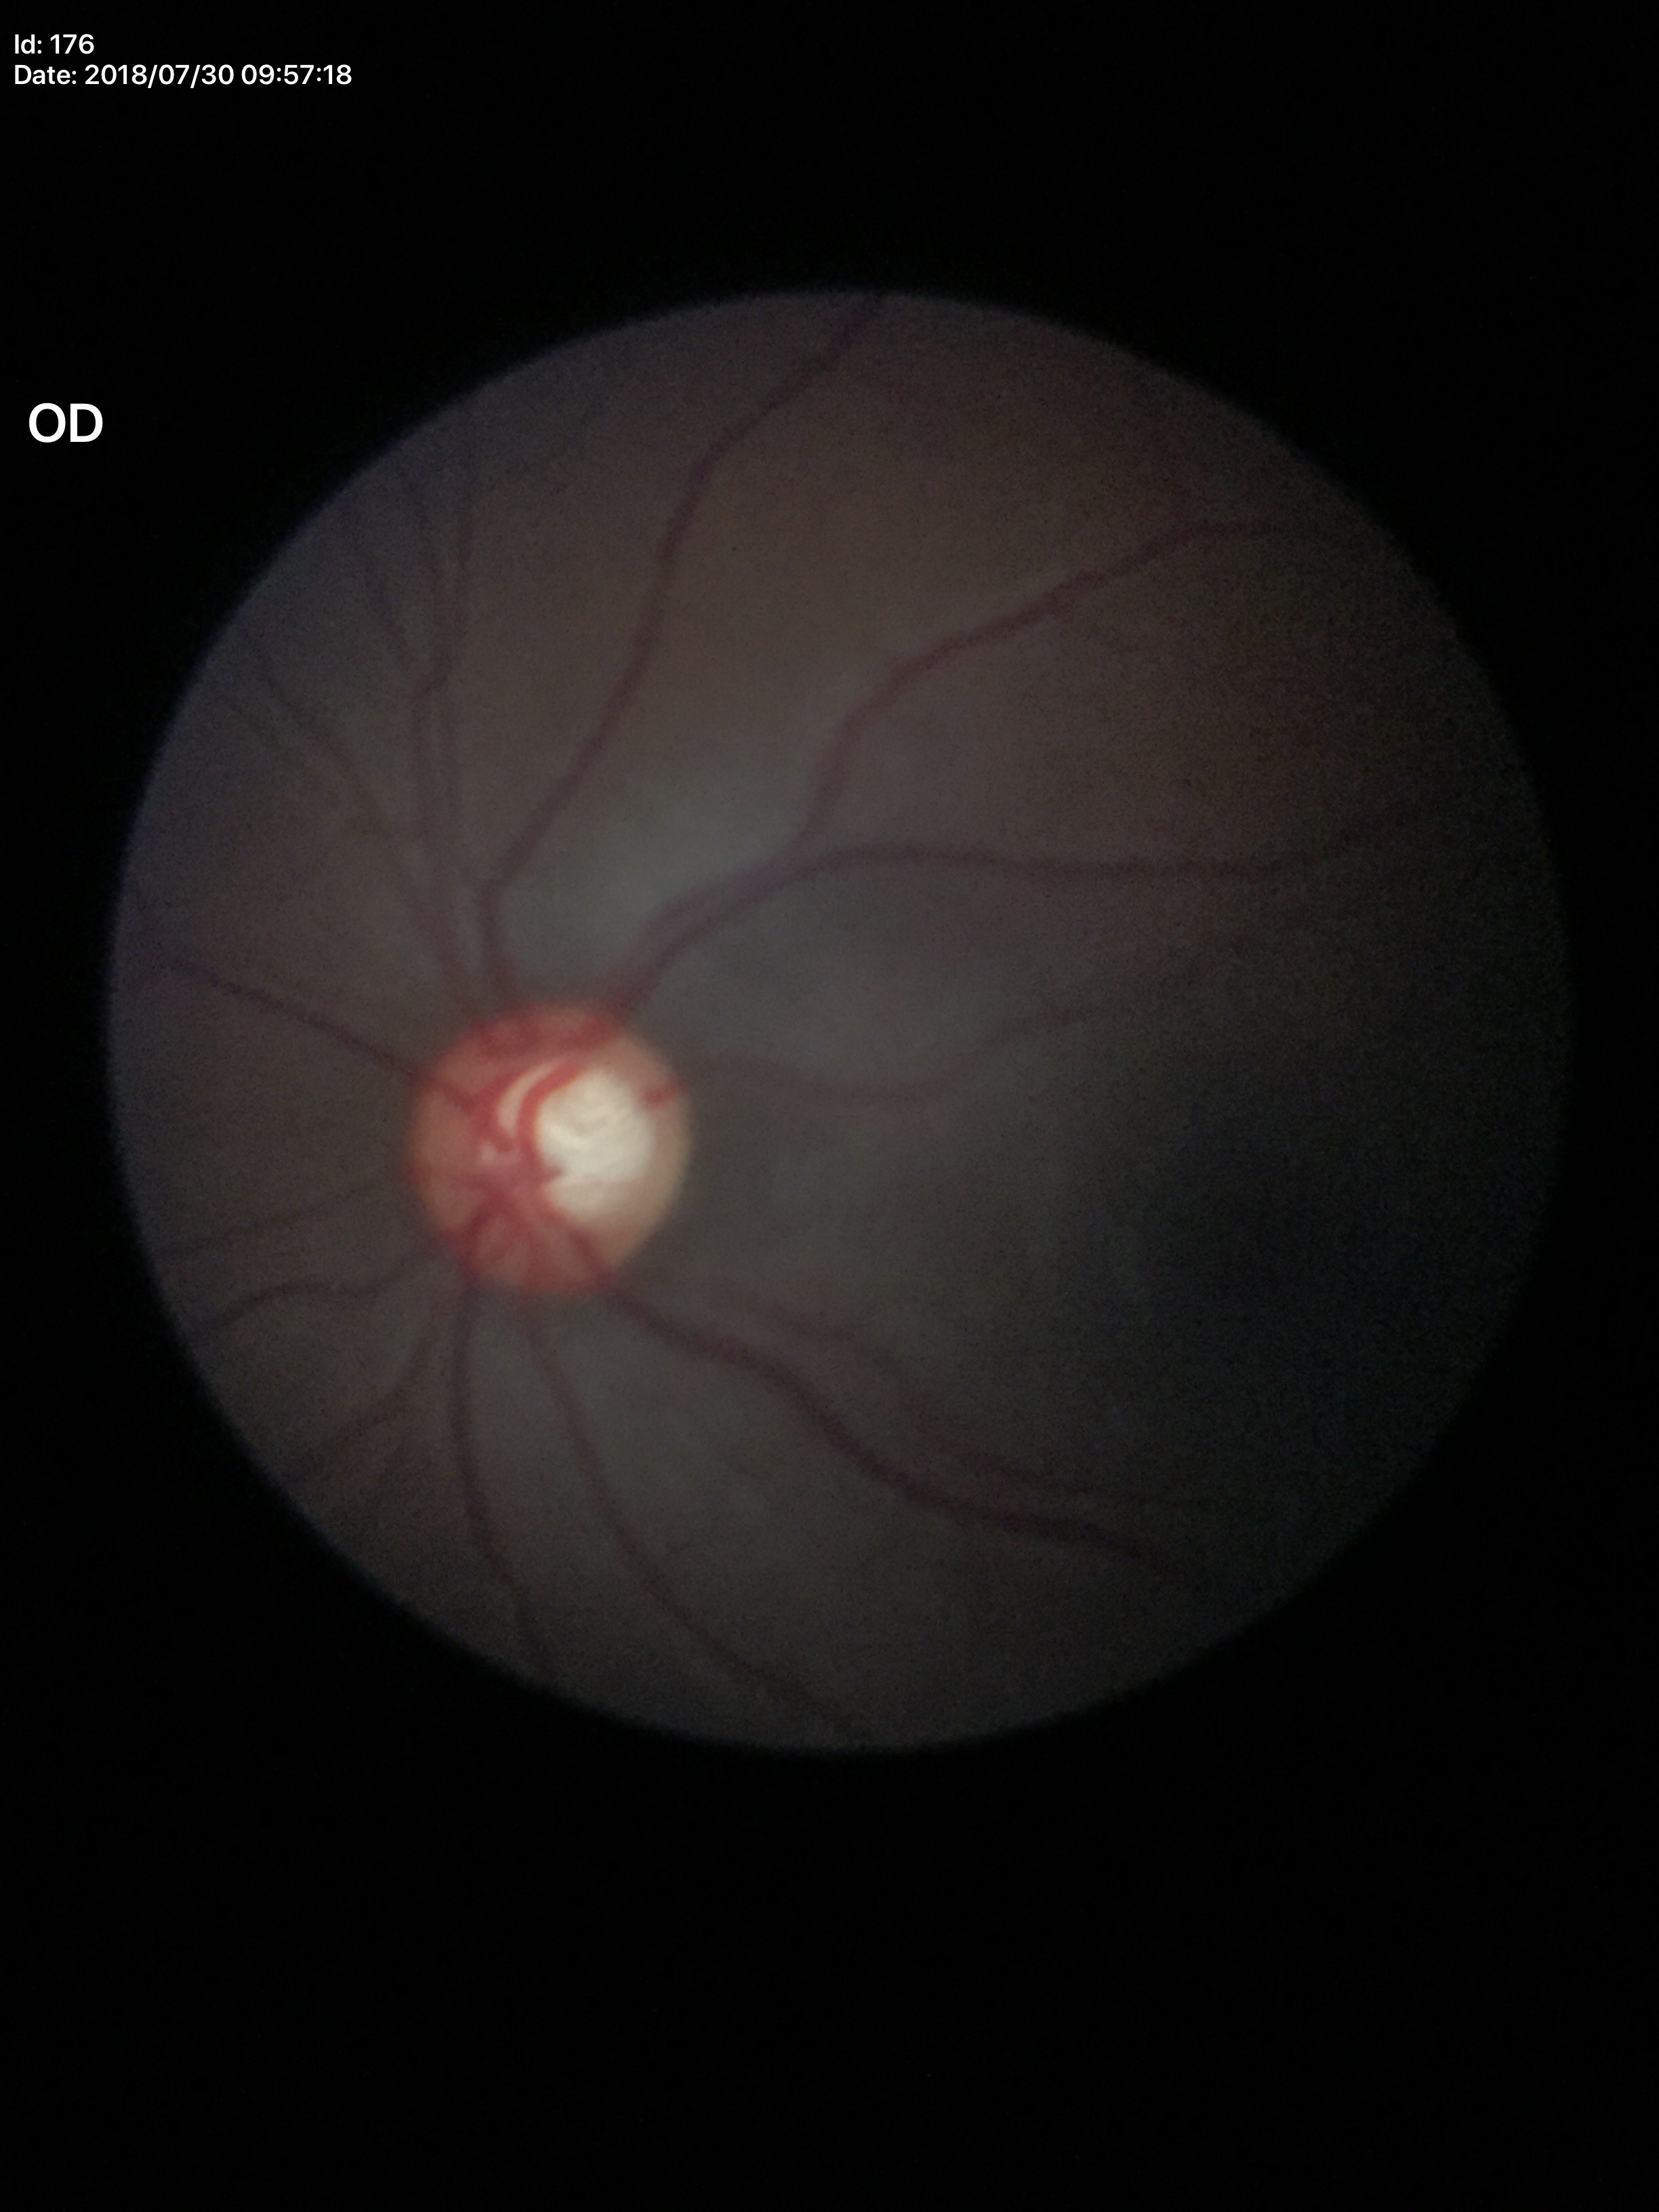

Vertical cup-to-disc ratio: 0.63.
Glaucoma assessment: suspect.
Horizontal cup-disc ratio of 0.63.